Davis DR grading — 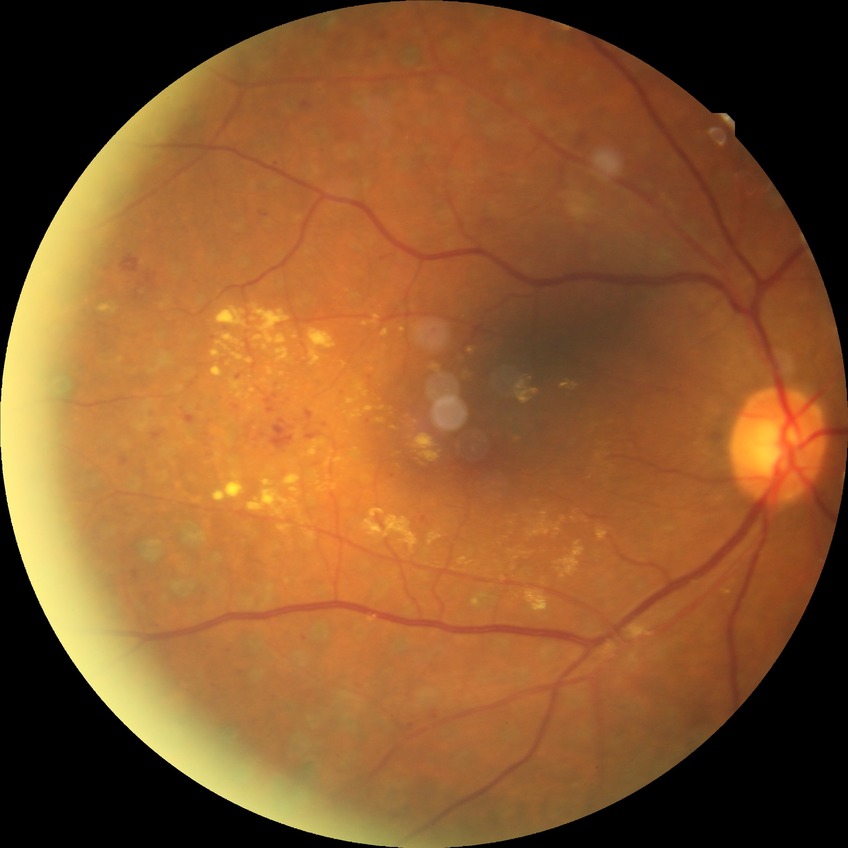
Modified Davis grading: proliferative diabetic retinopathy.